NIDEK AFC-230. Nonmydriatic fundus photograph. Diabetic retinopathy graded by the modified Davis classification — 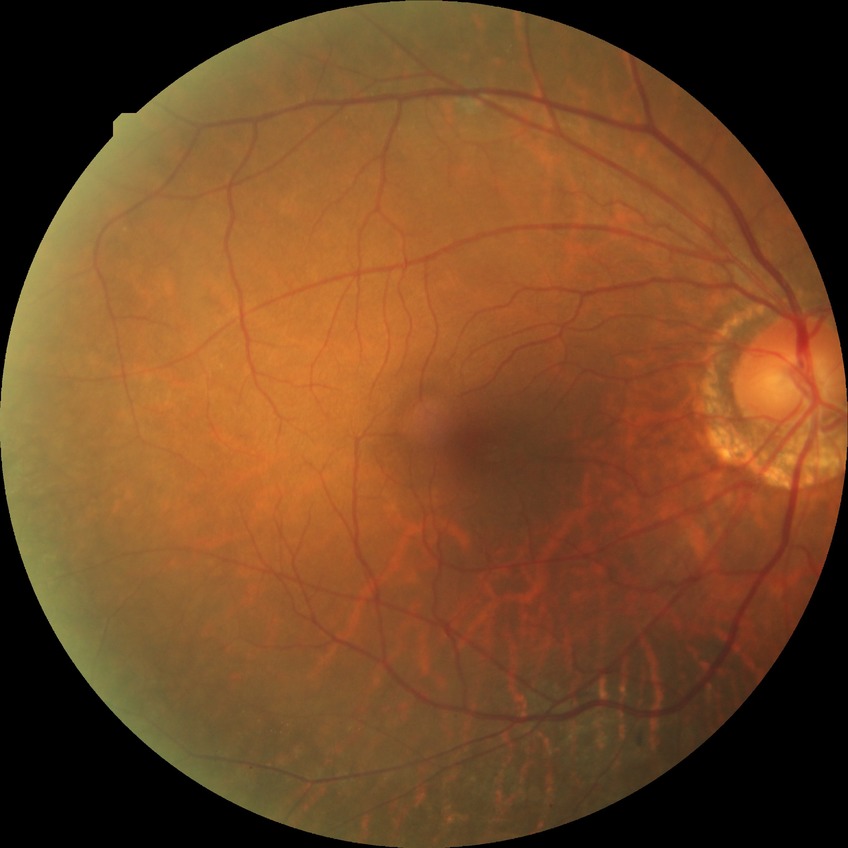 Annotations:
* diabetic retinopathy (DR): NDR (no diabetic retinopathy)